Fundus photo. 45° field of view:
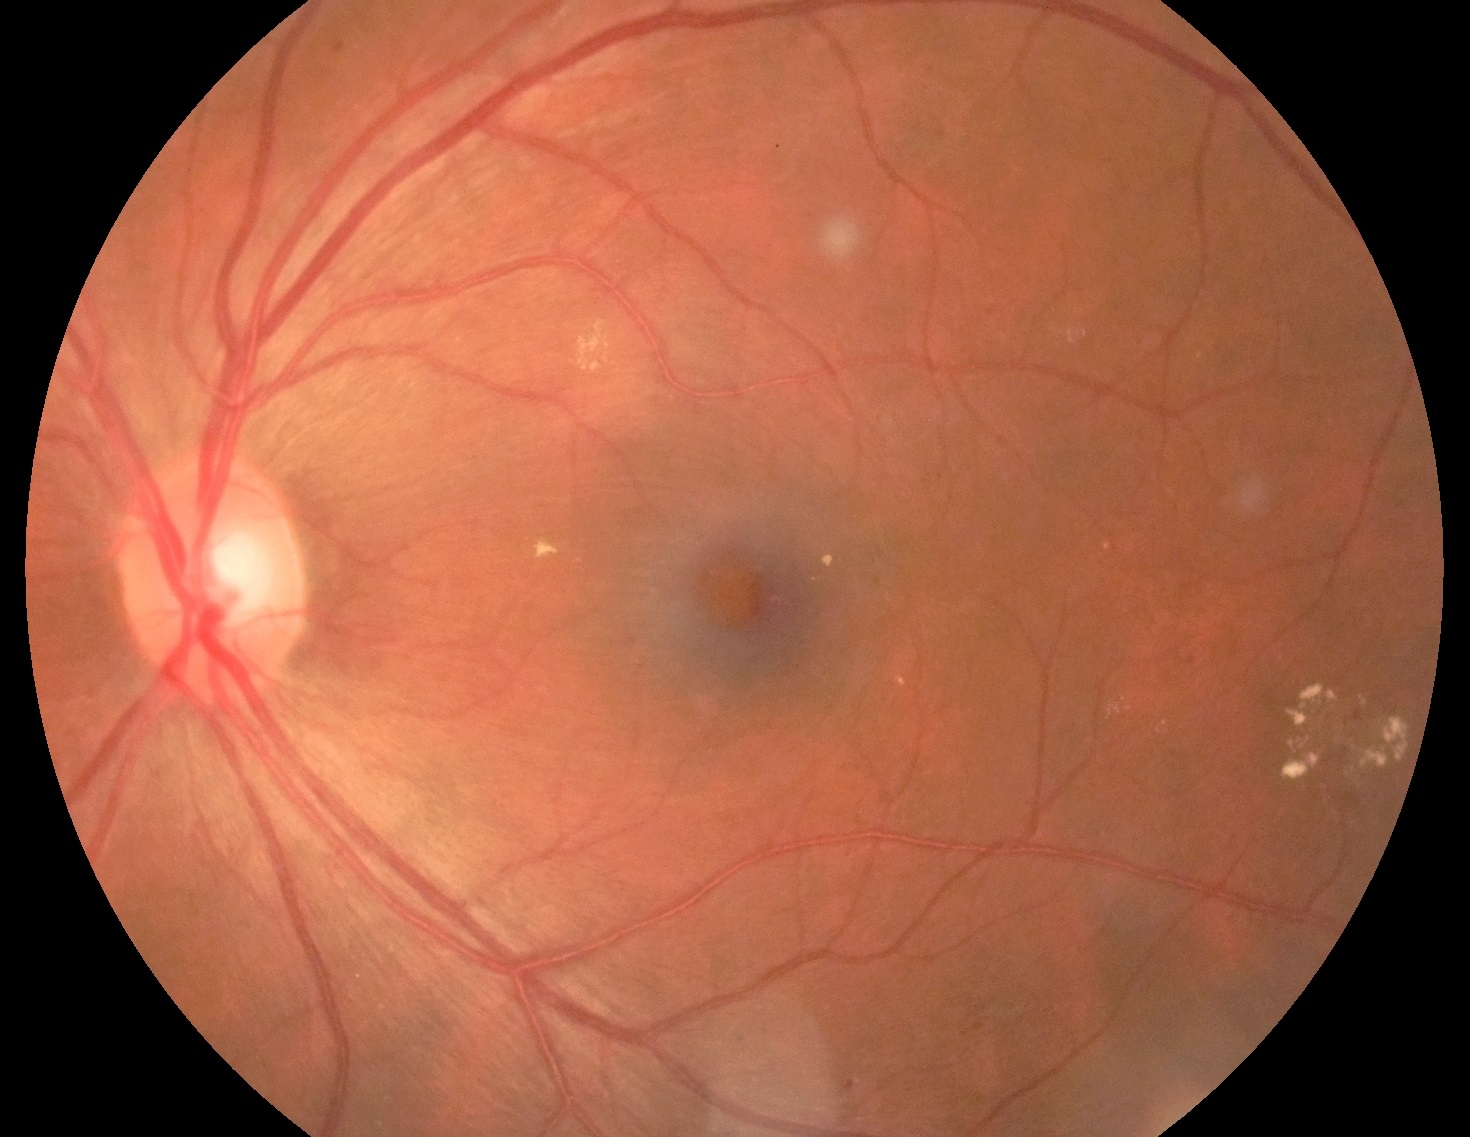 {"dr_grade": "moderate NPDR (grade 2)", "dr_category": "non-proliferative diabetic retinopathy"}